Retinal fundus photograph; image size 1659x2212.
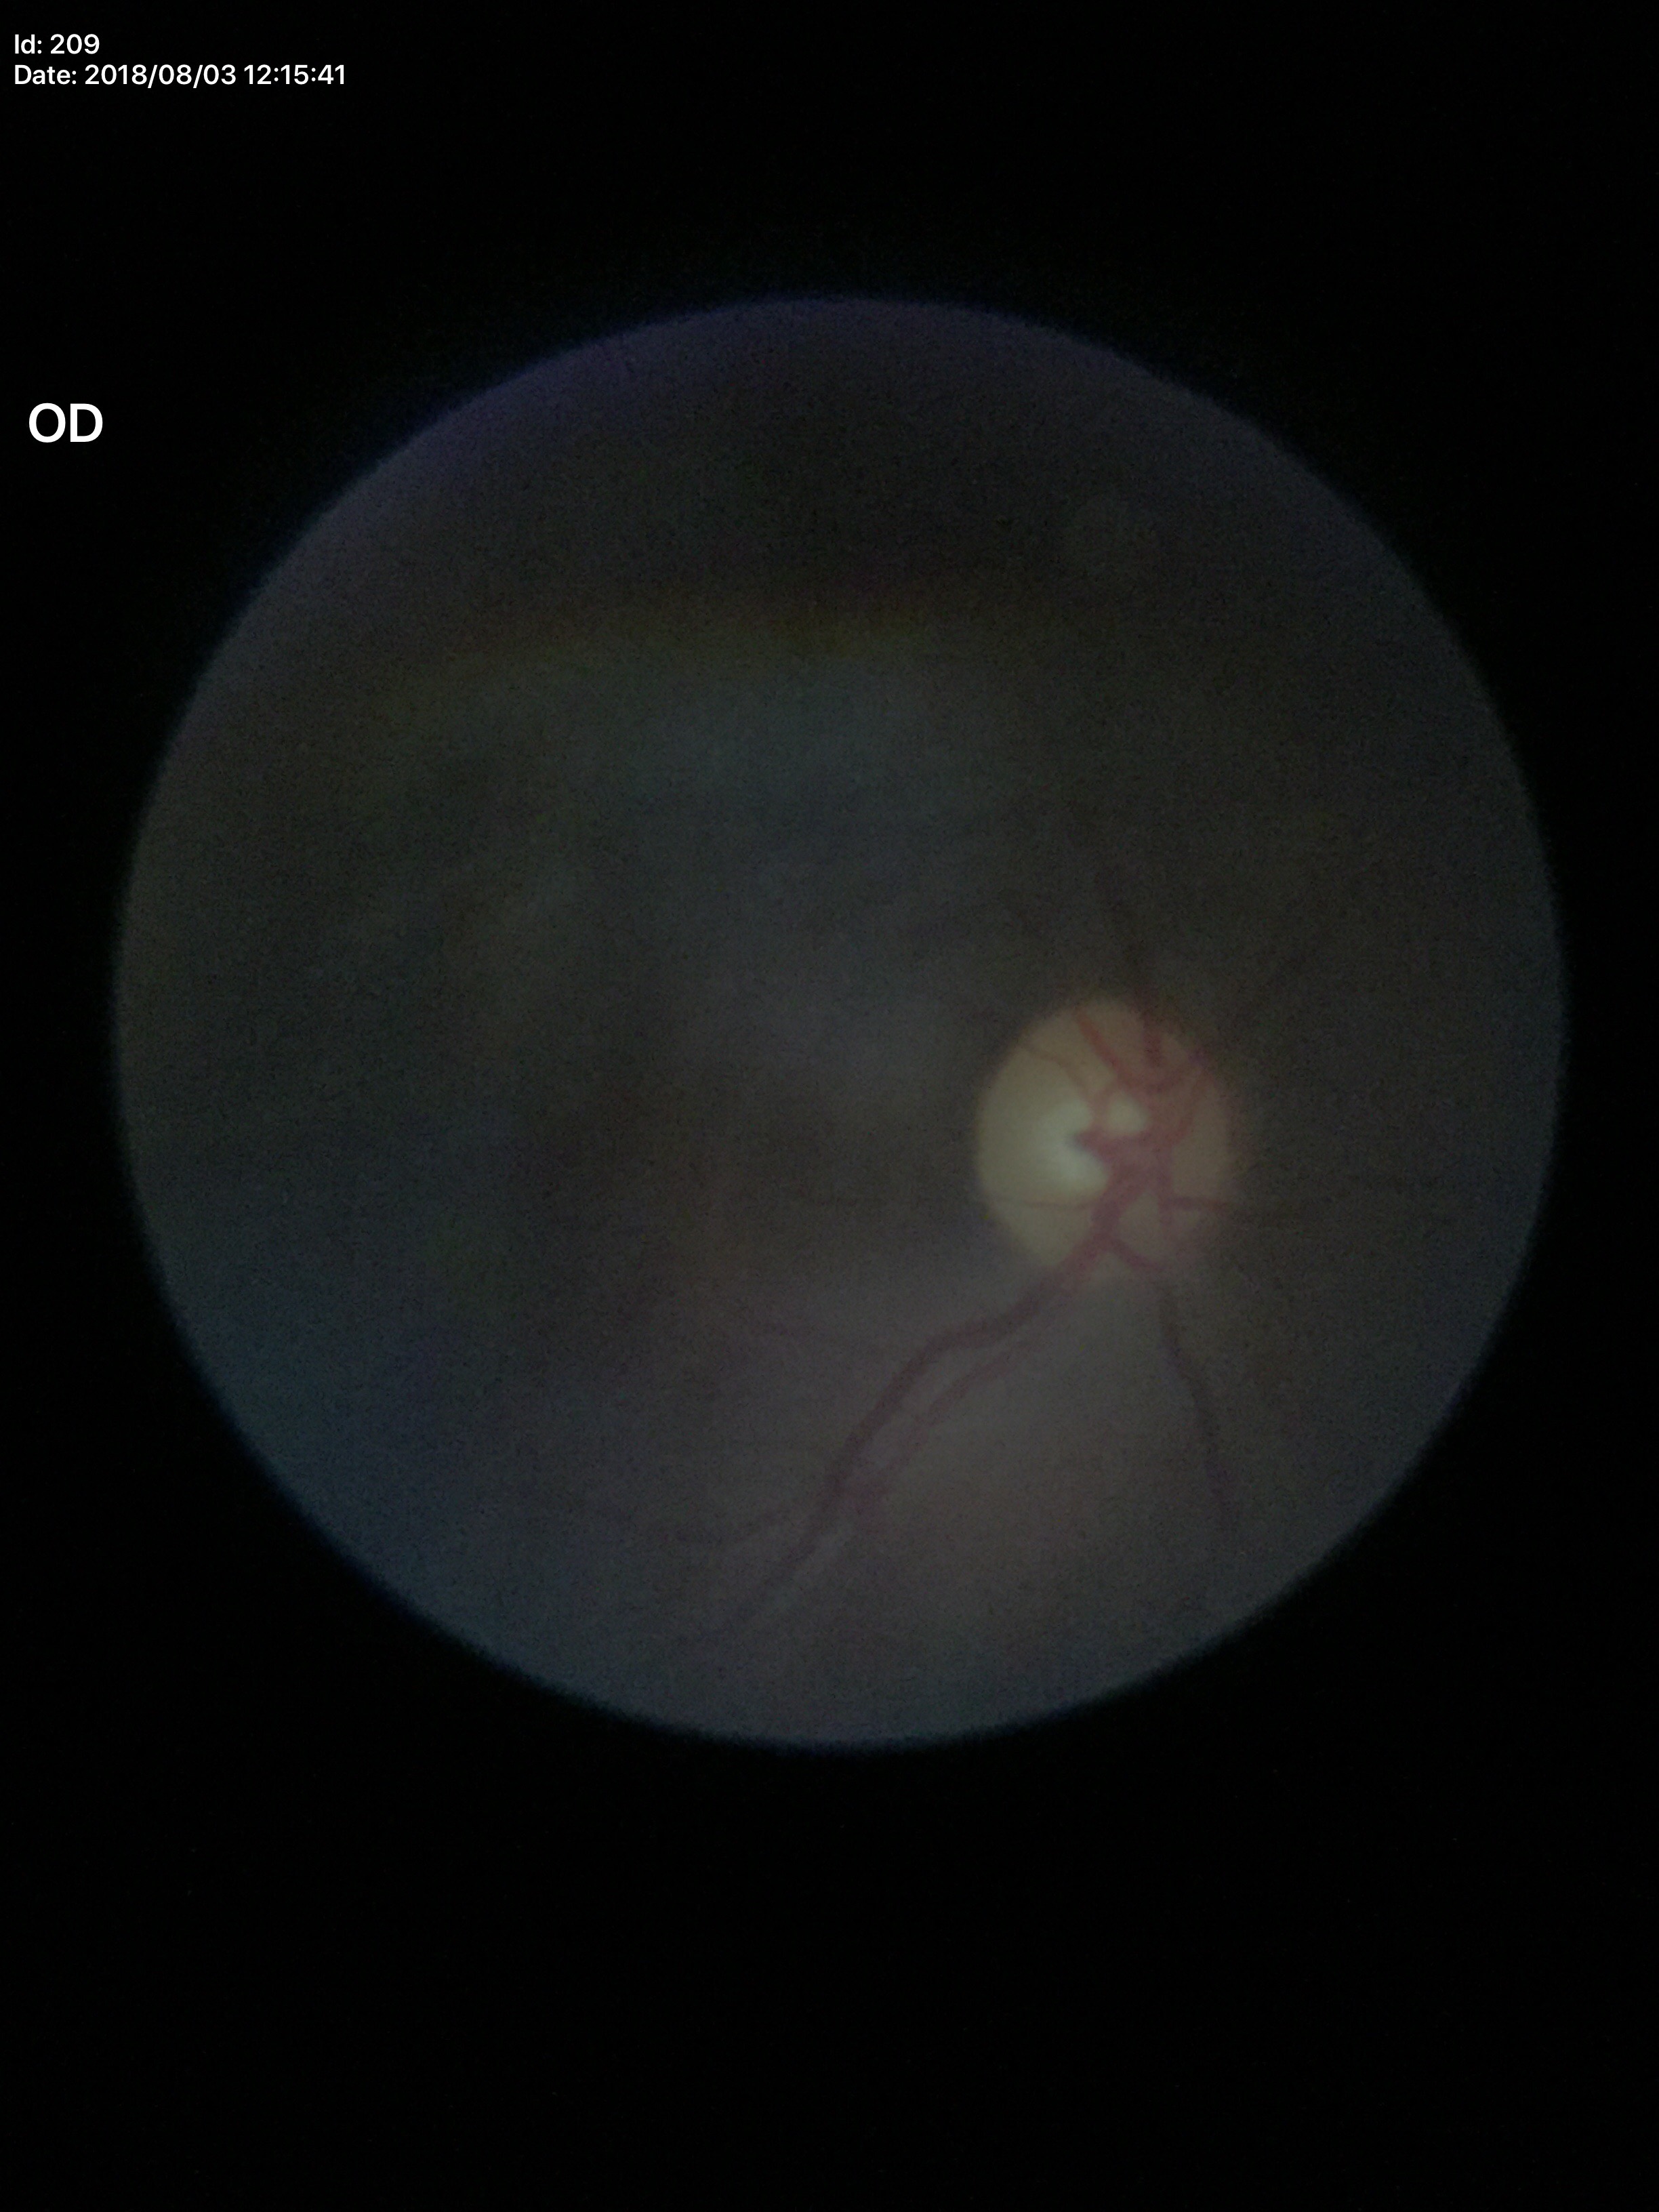
No signs of glaucoma. VCDR is 0.52.